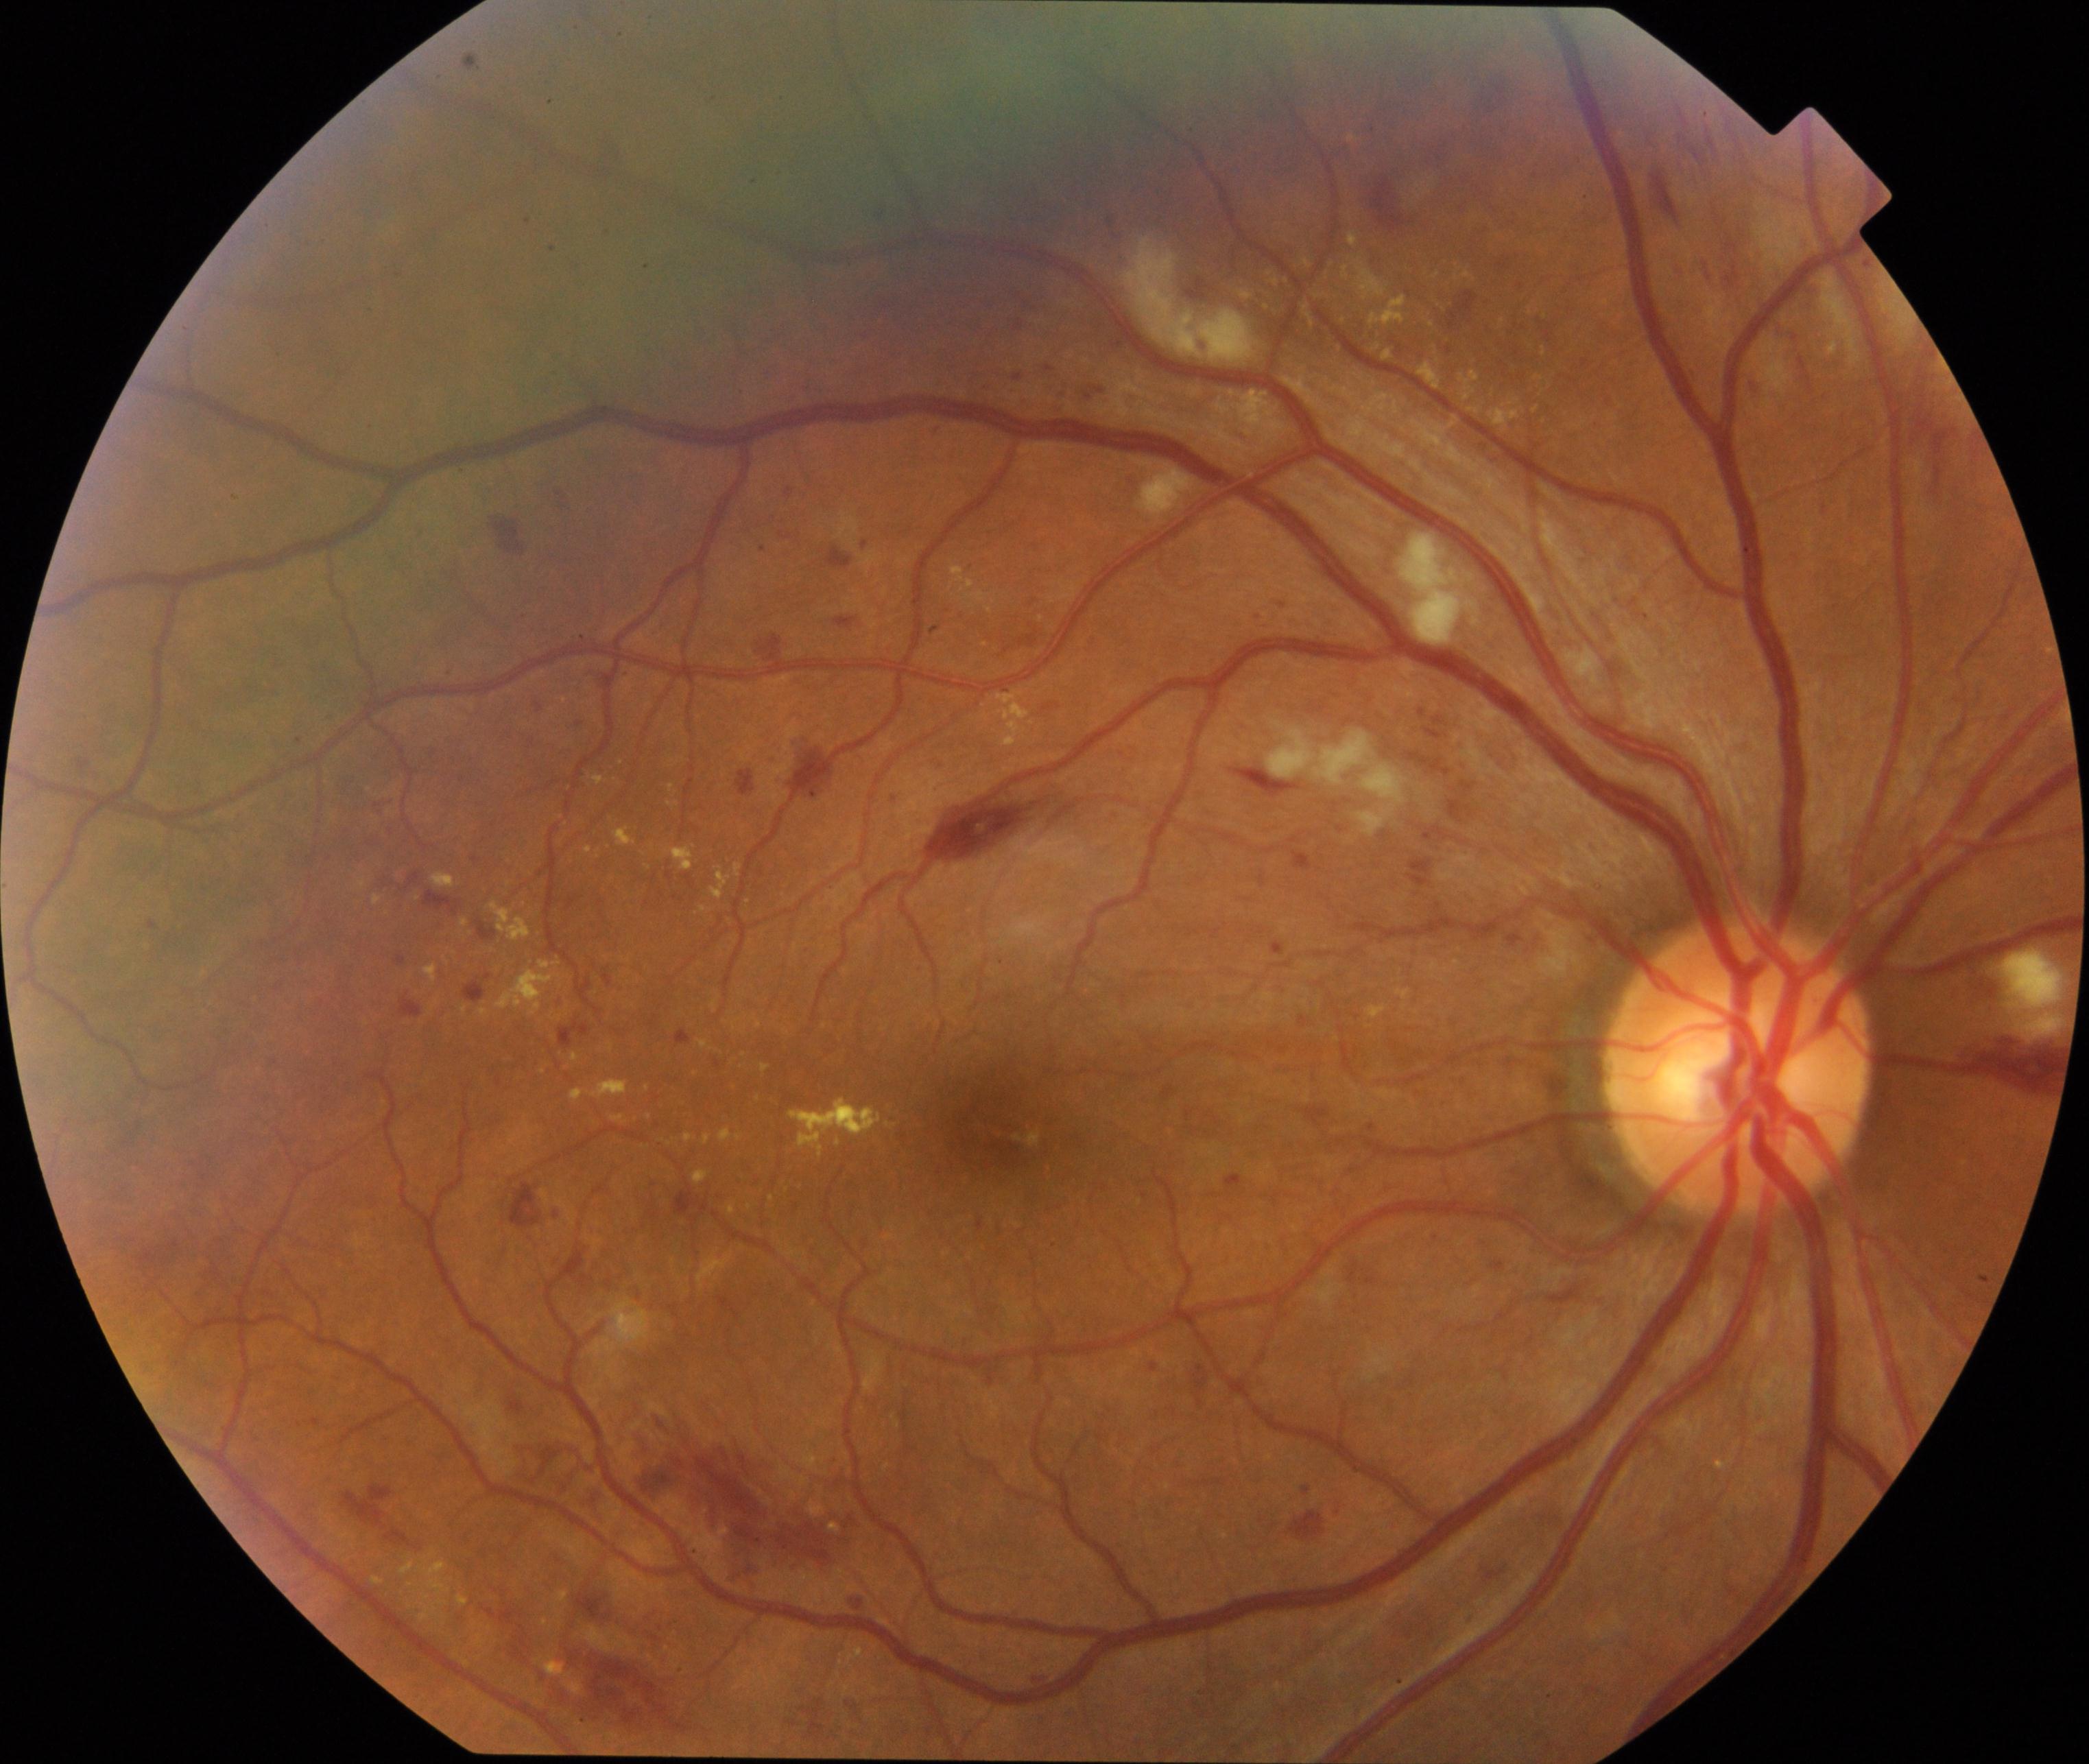

Consistent with moderate non-proliferative diabetic retinopathy. Characterized by microaneurysms with dot and blot hemorrhages or hard exudates, less than severe non-proliferative diabetic retinopathy, and/or with diabetic macular edema.